Infant wide-field fundus photograph. Camera: Clarity RetCam 3 (130° FOV):
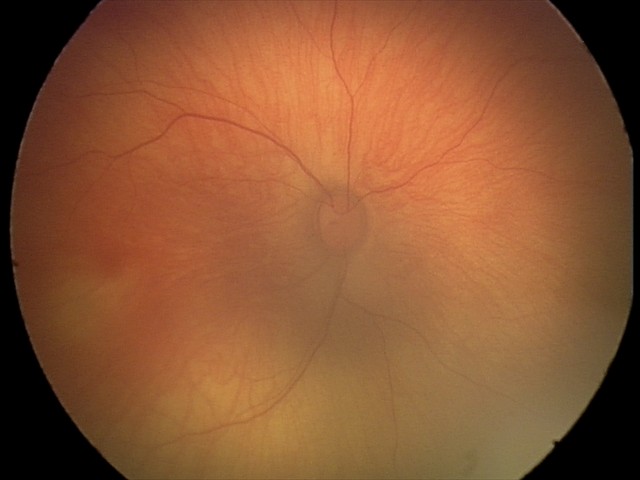
Diagnosis from this screening exam: retinal hemorrhages.